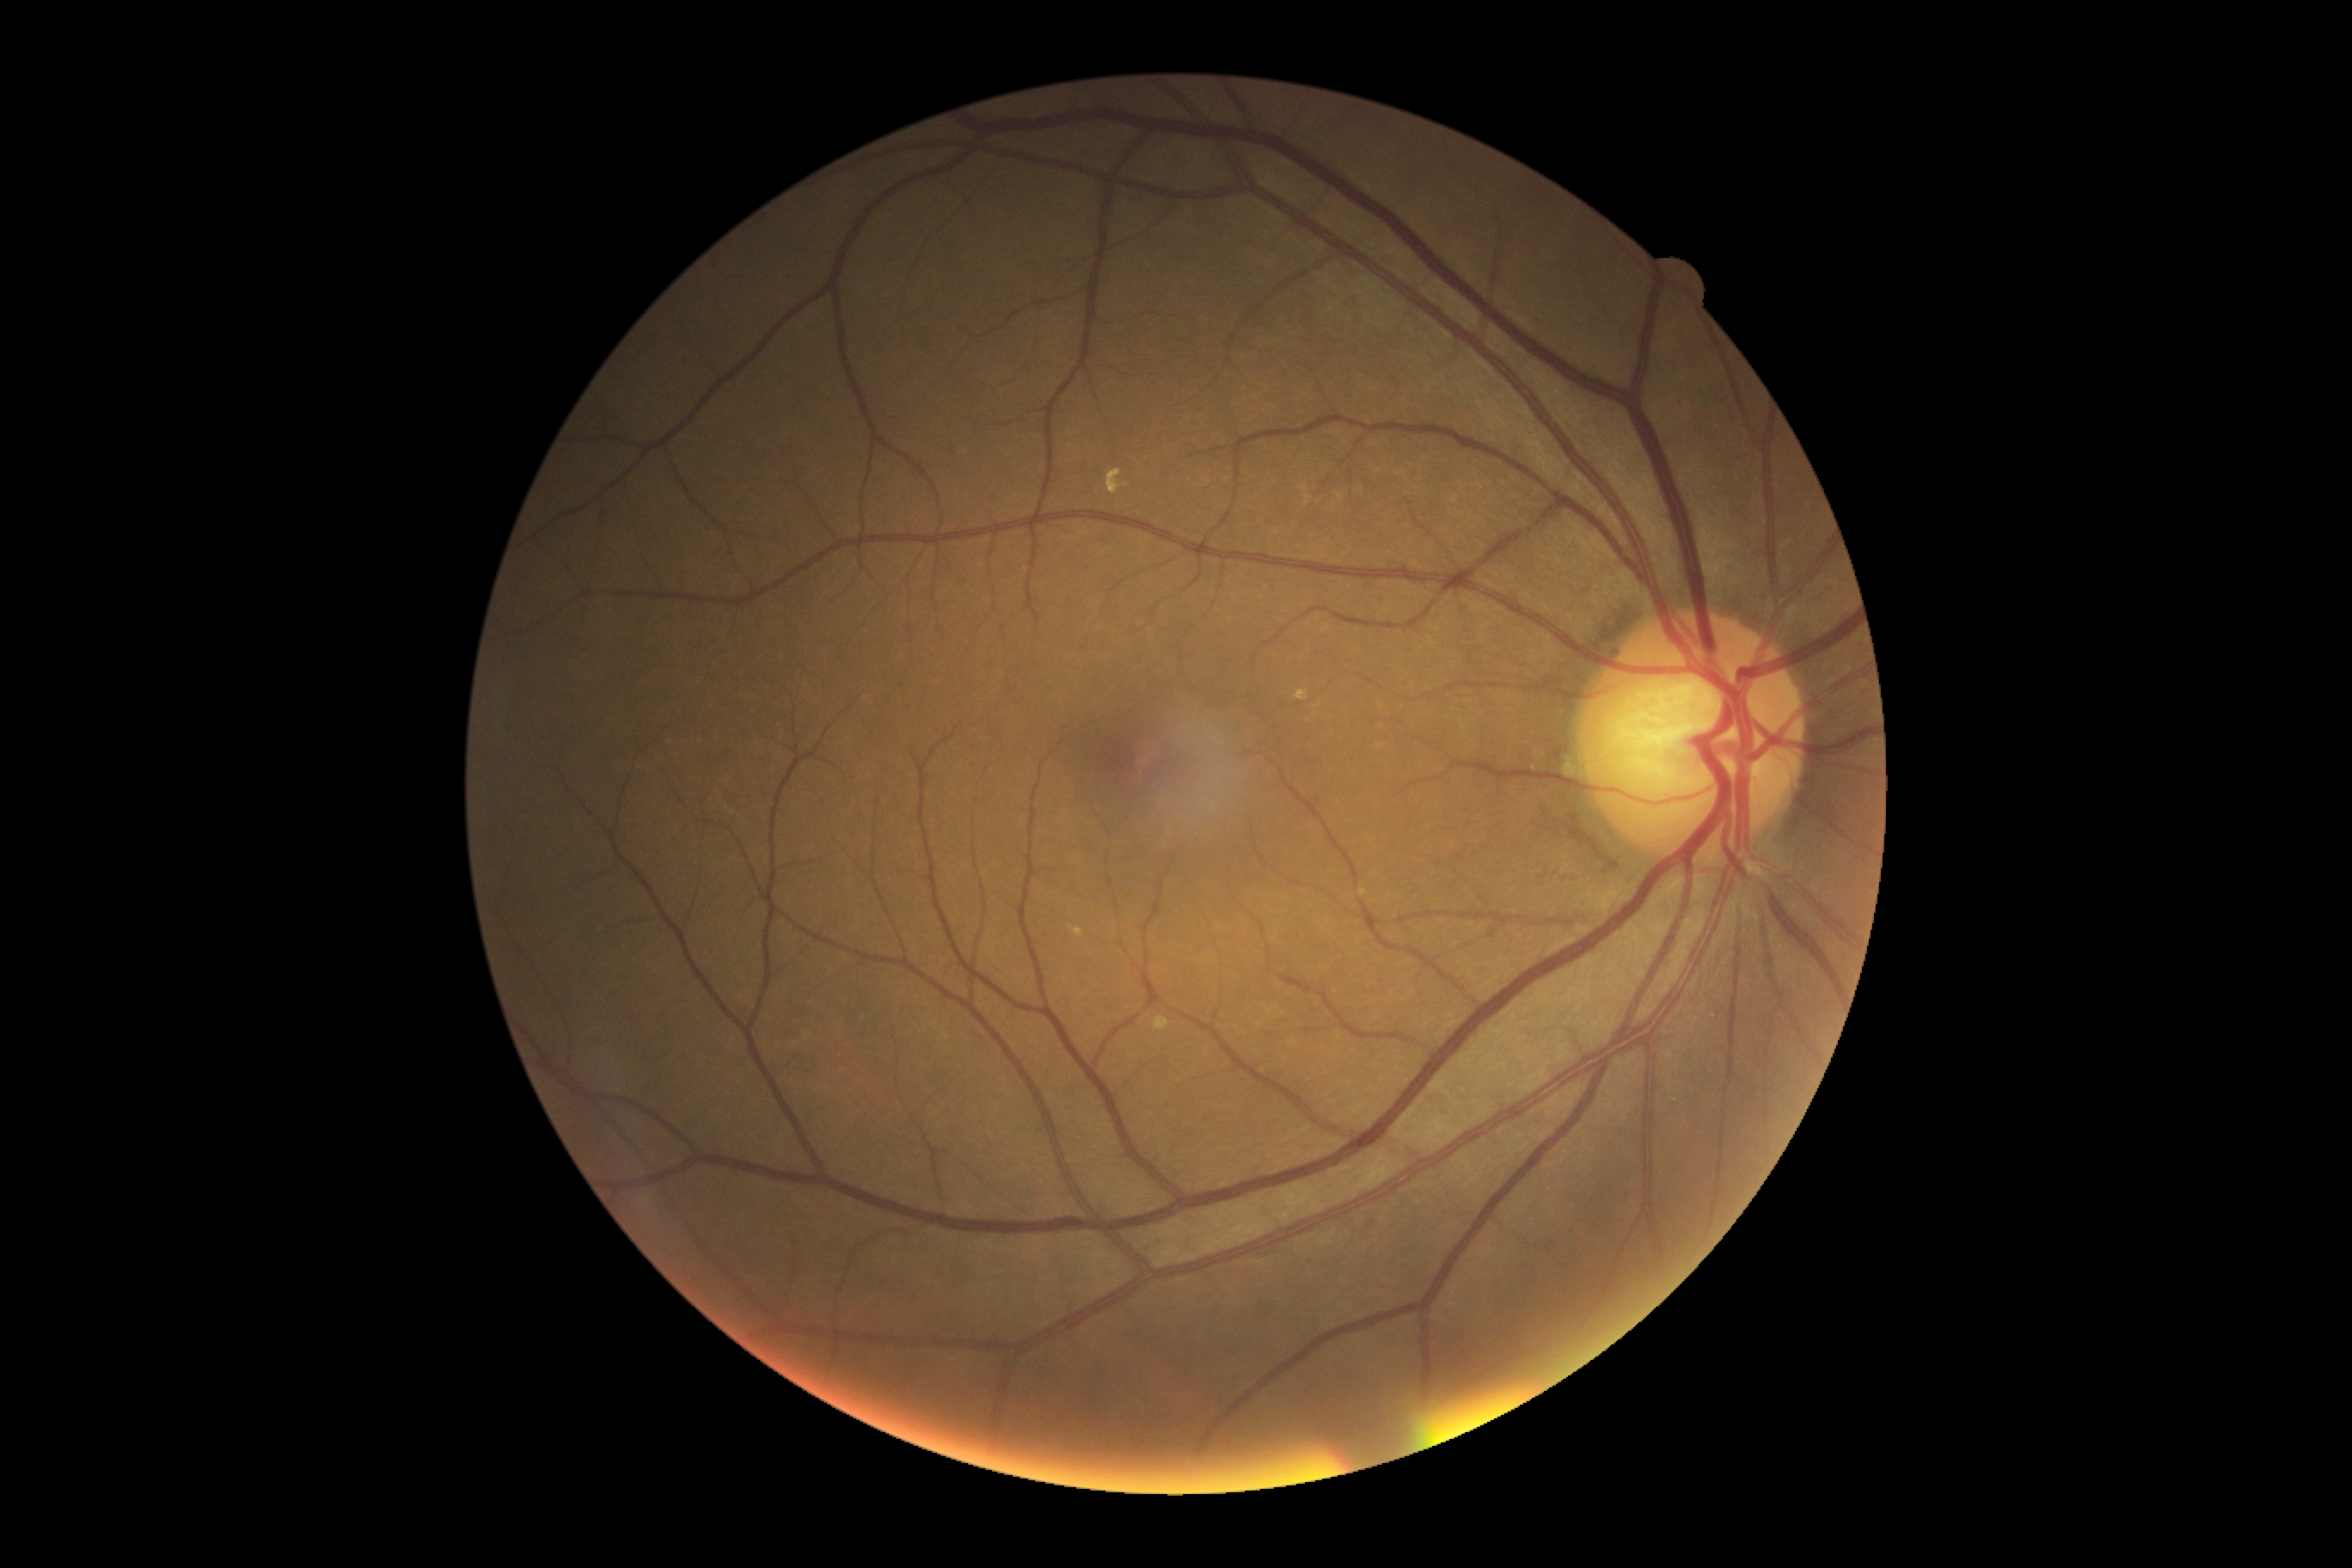
diabetic retinopathy (DR) = grade 0 (no apparent retinopathy)